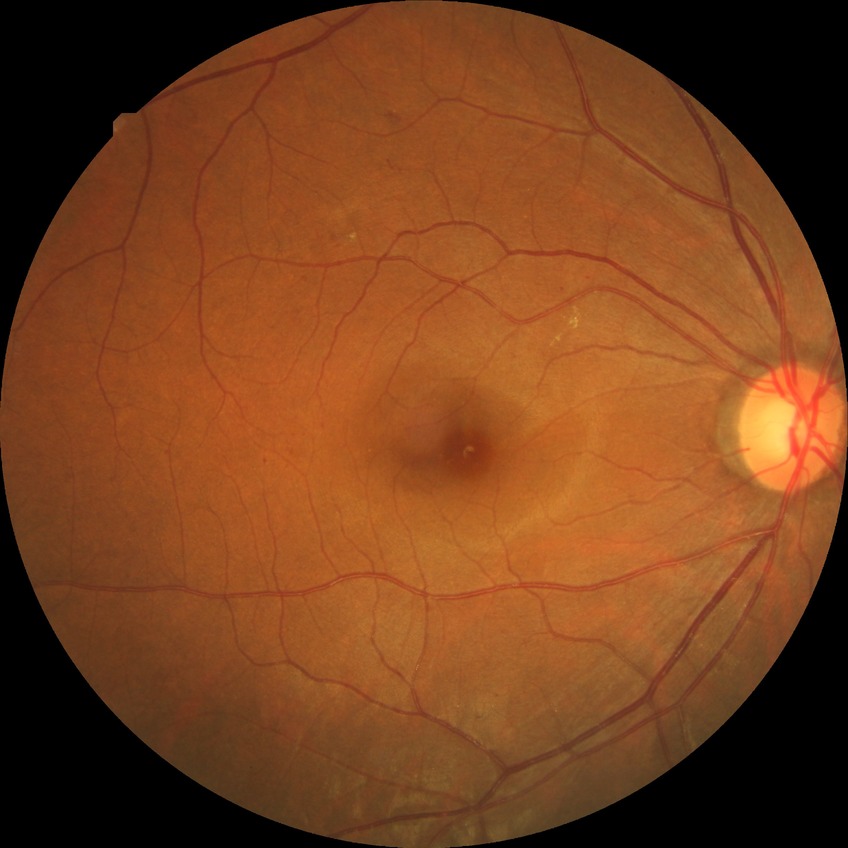 retinopathy grade: simple diabetic retinopathy; DR class: non-proliferative diabetic retinopathy.